Infant wide-field retinal image; acquired on the Clarity RetCam 3 — 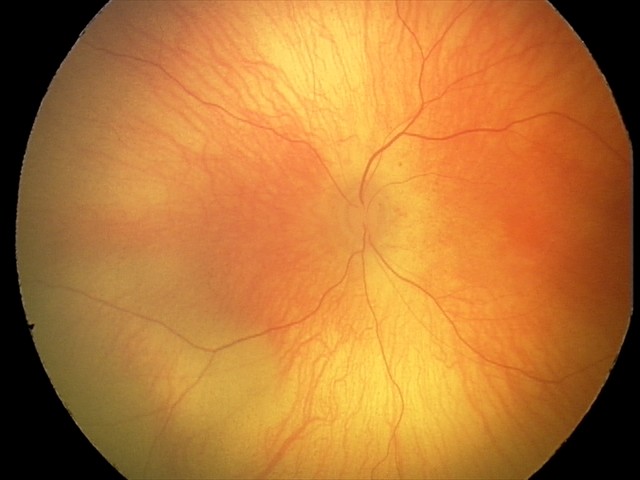
Screening examination with no abnormal retinal findings.